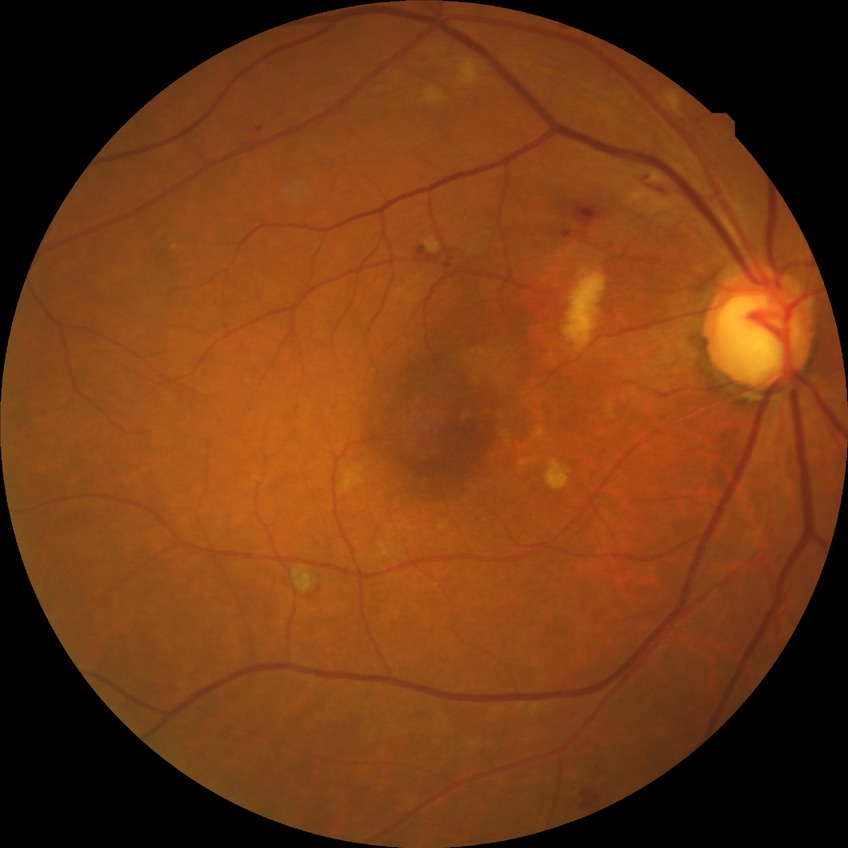
retinopathy stage: pre-proliferative diabetic retinopathy | DR class: non-proliferative diabetic retinopathy.